Pediatric retinal photograph (wide-field).
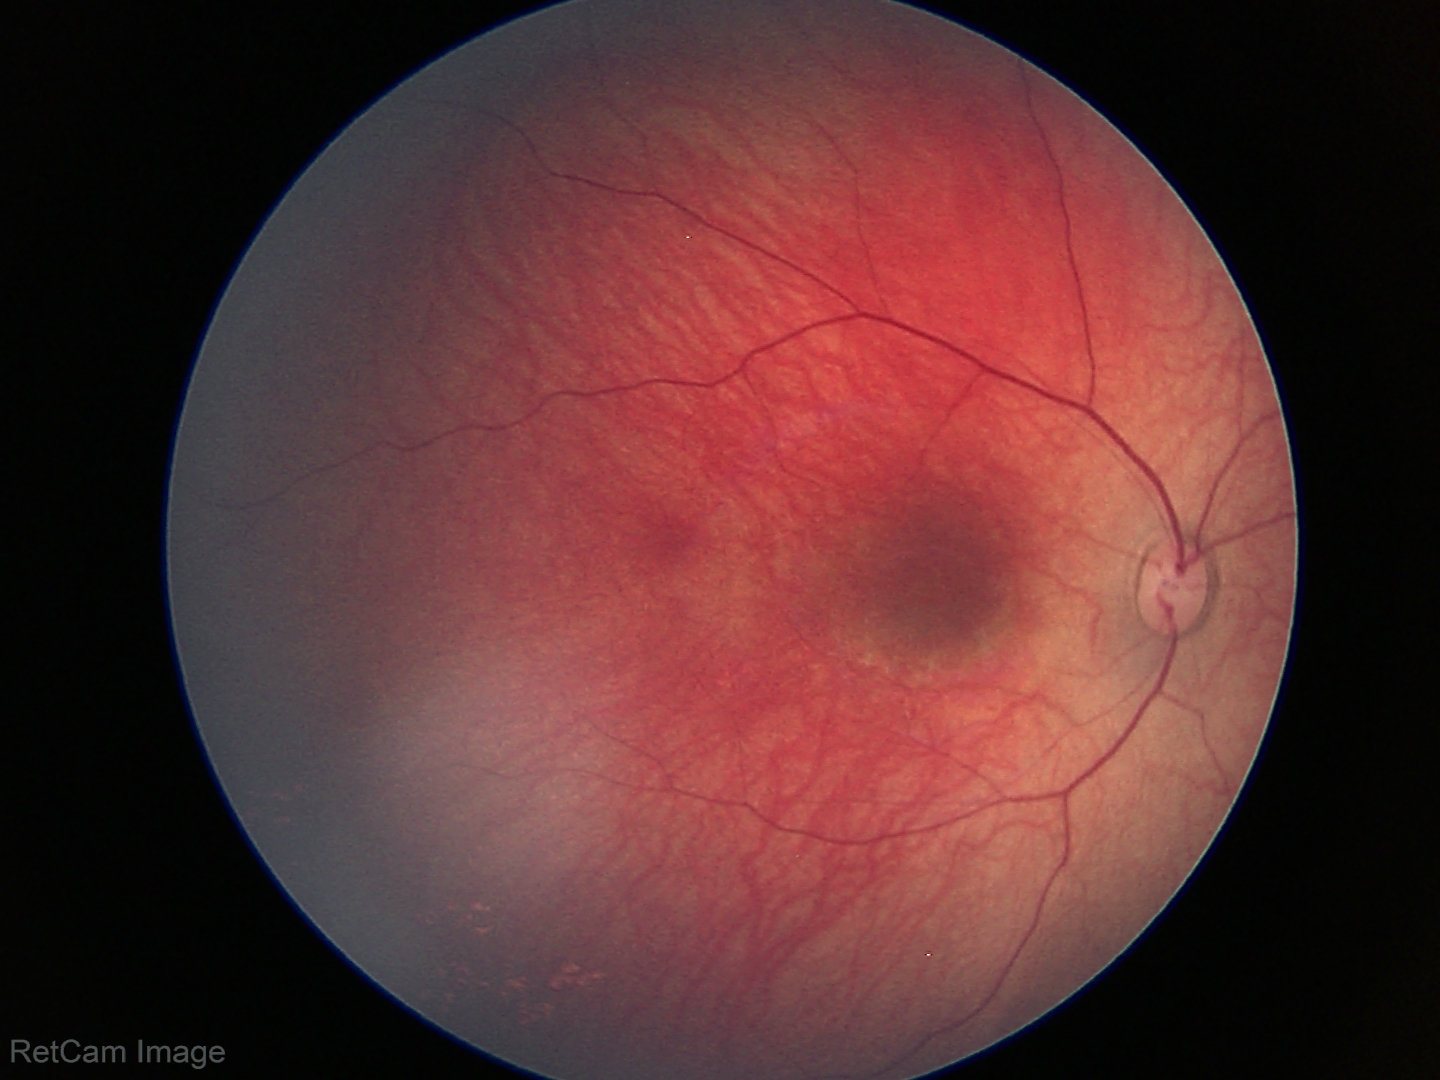
Assessment: normal retinal appearance.